45-degree field of view. 2352x1568. CFP.
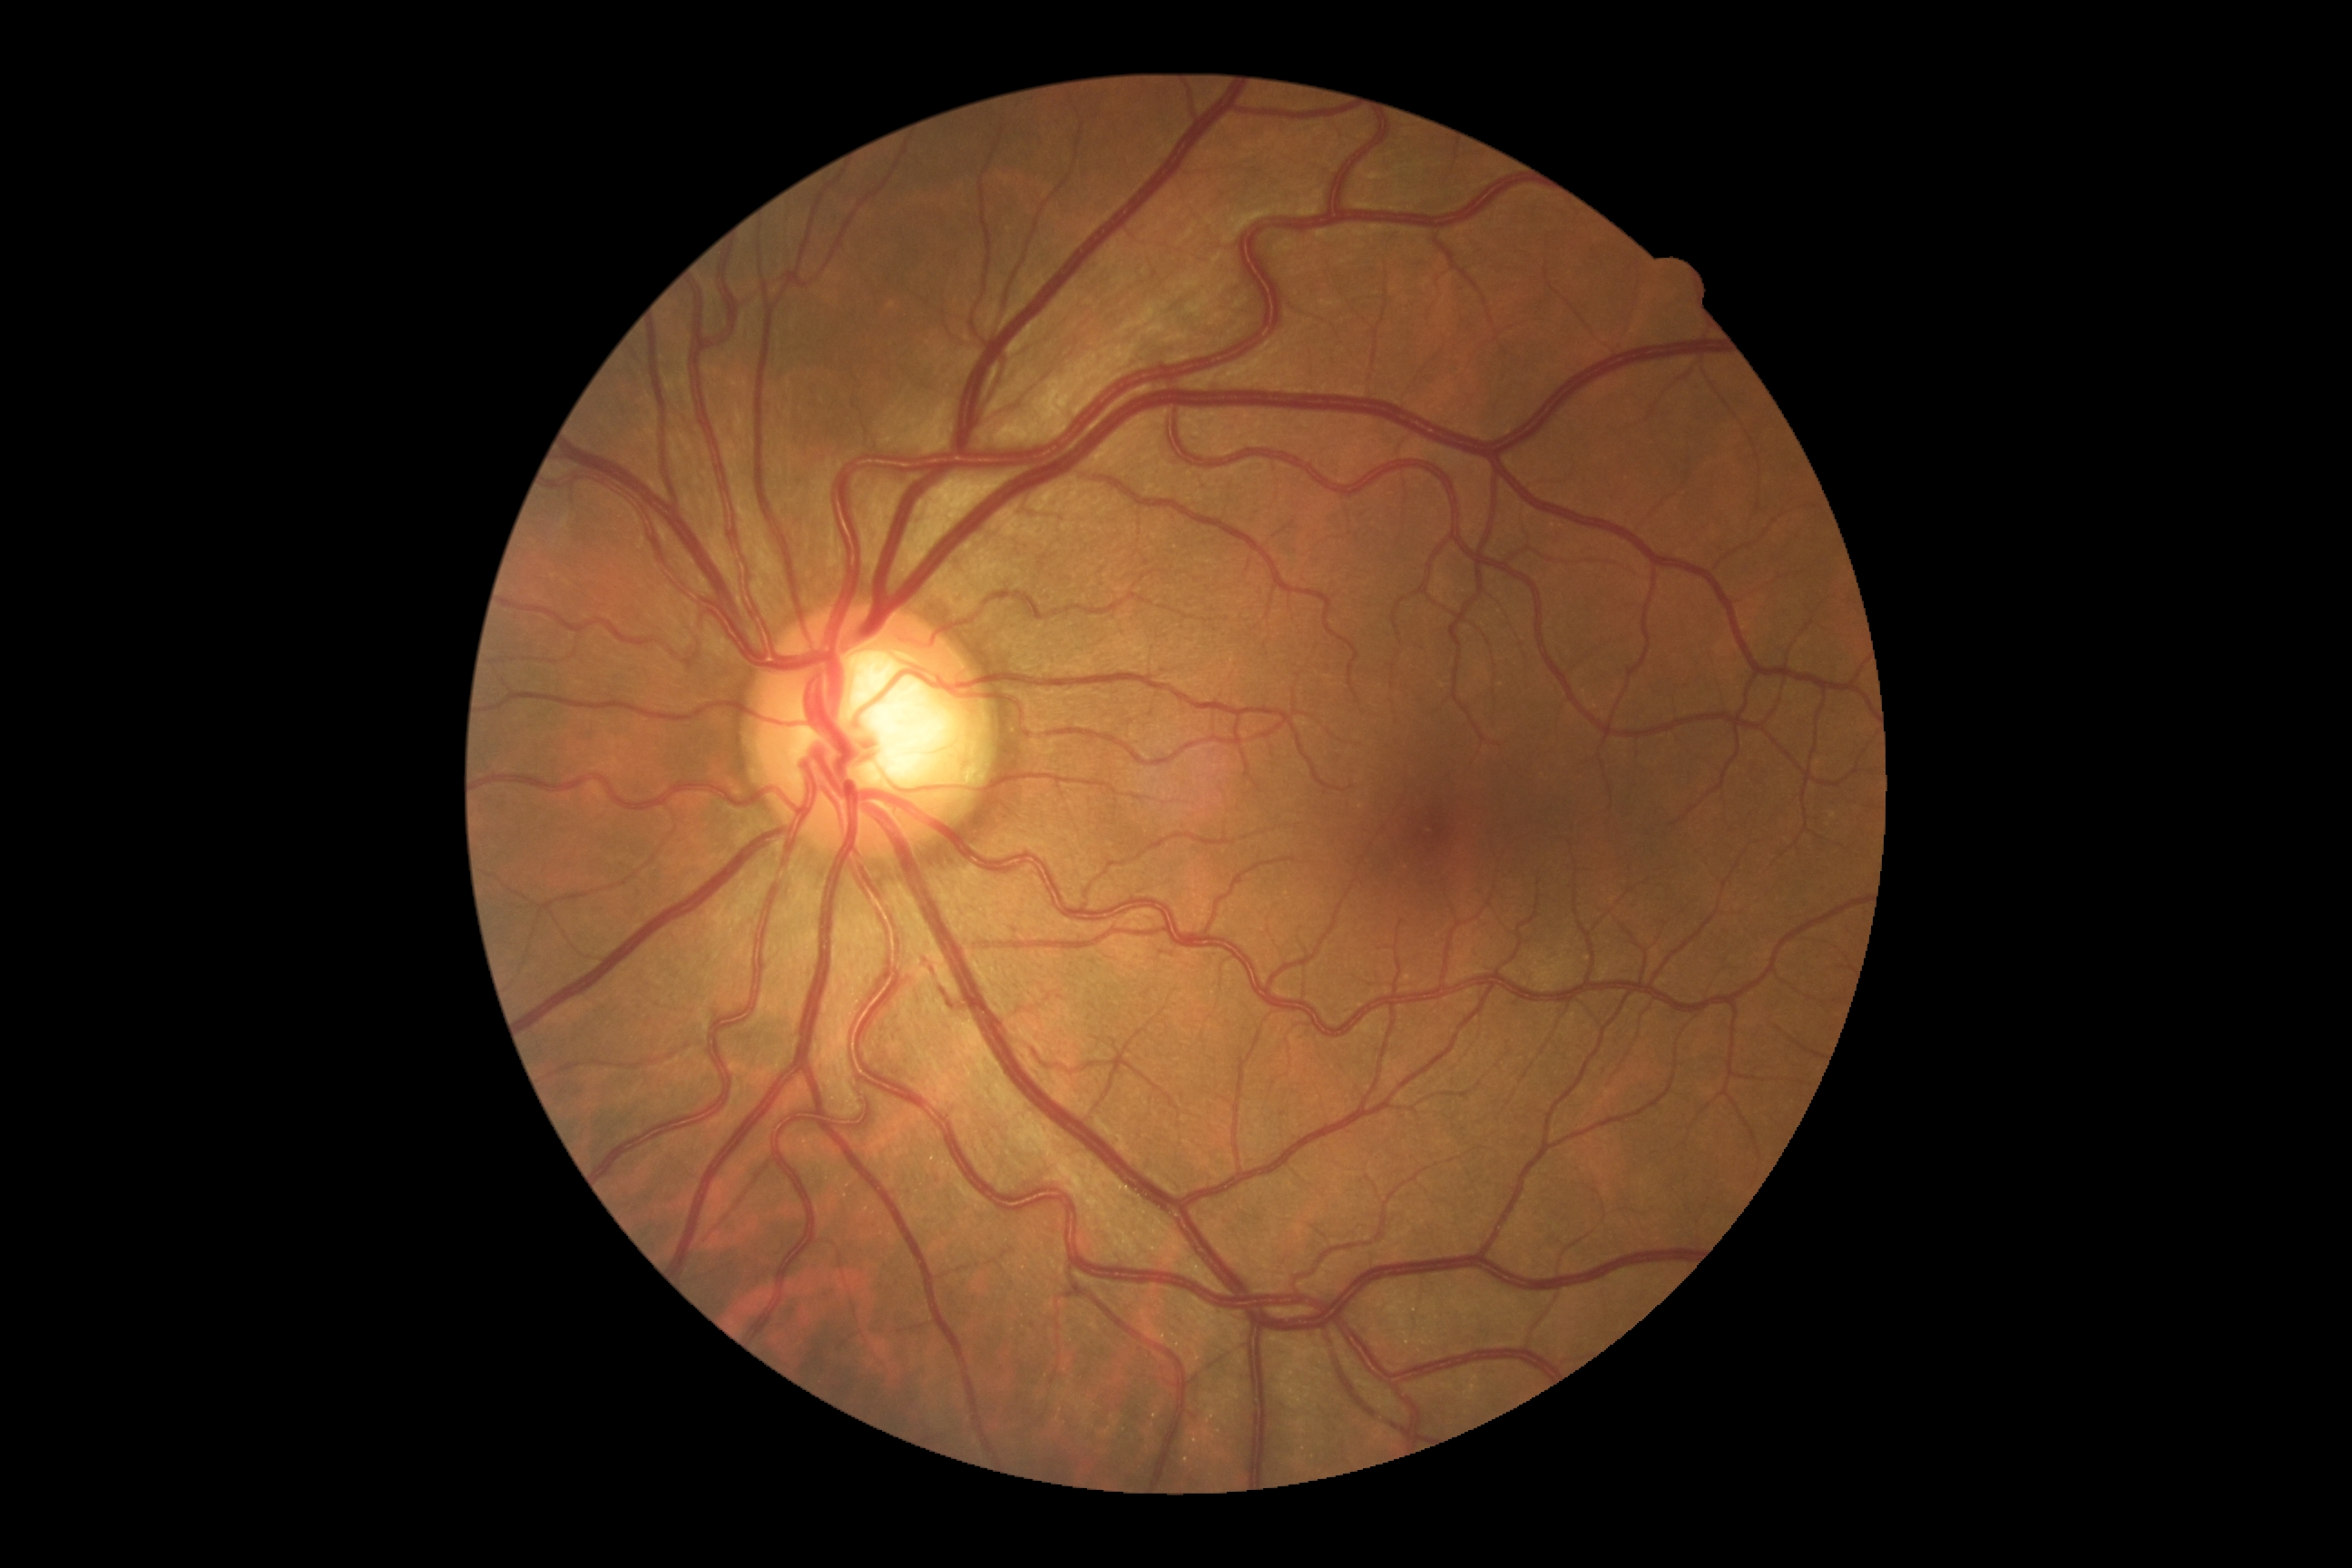
DR class: non-proliferative diabetic retinopathy.
DR: moderate non-proliferative diabetic retinopathy (grade 2) — more than just microaneurysms but less than severe NPDR.